45 degree fundus photograph: 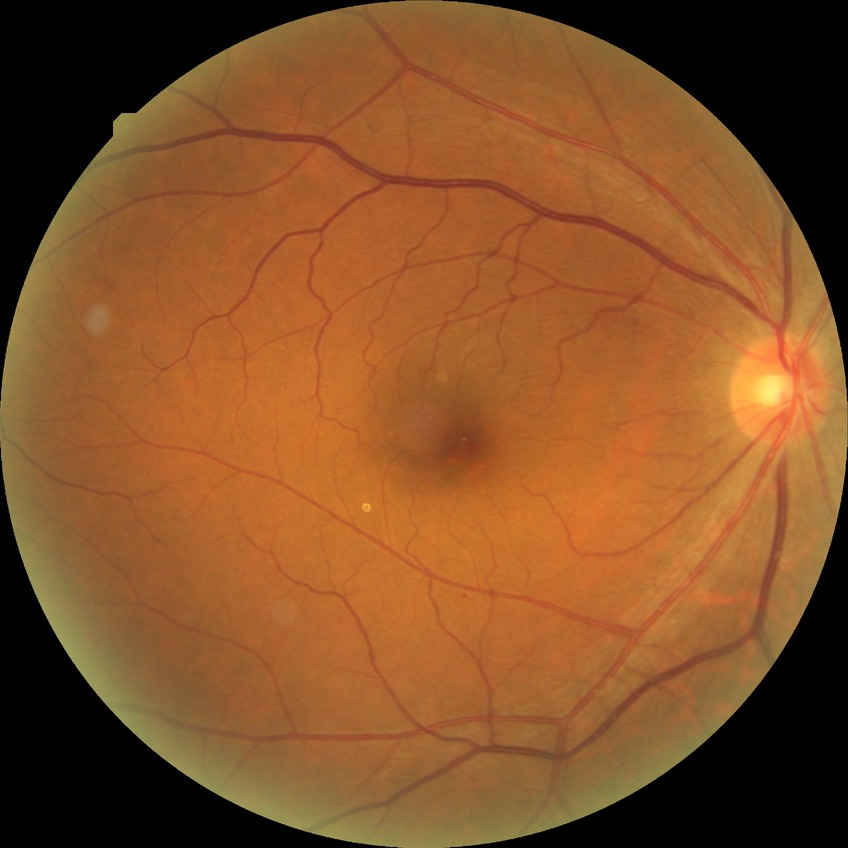 Assessment:
* diabetic retinopathy (DR) — simple diabetic retinopathy (SDR)